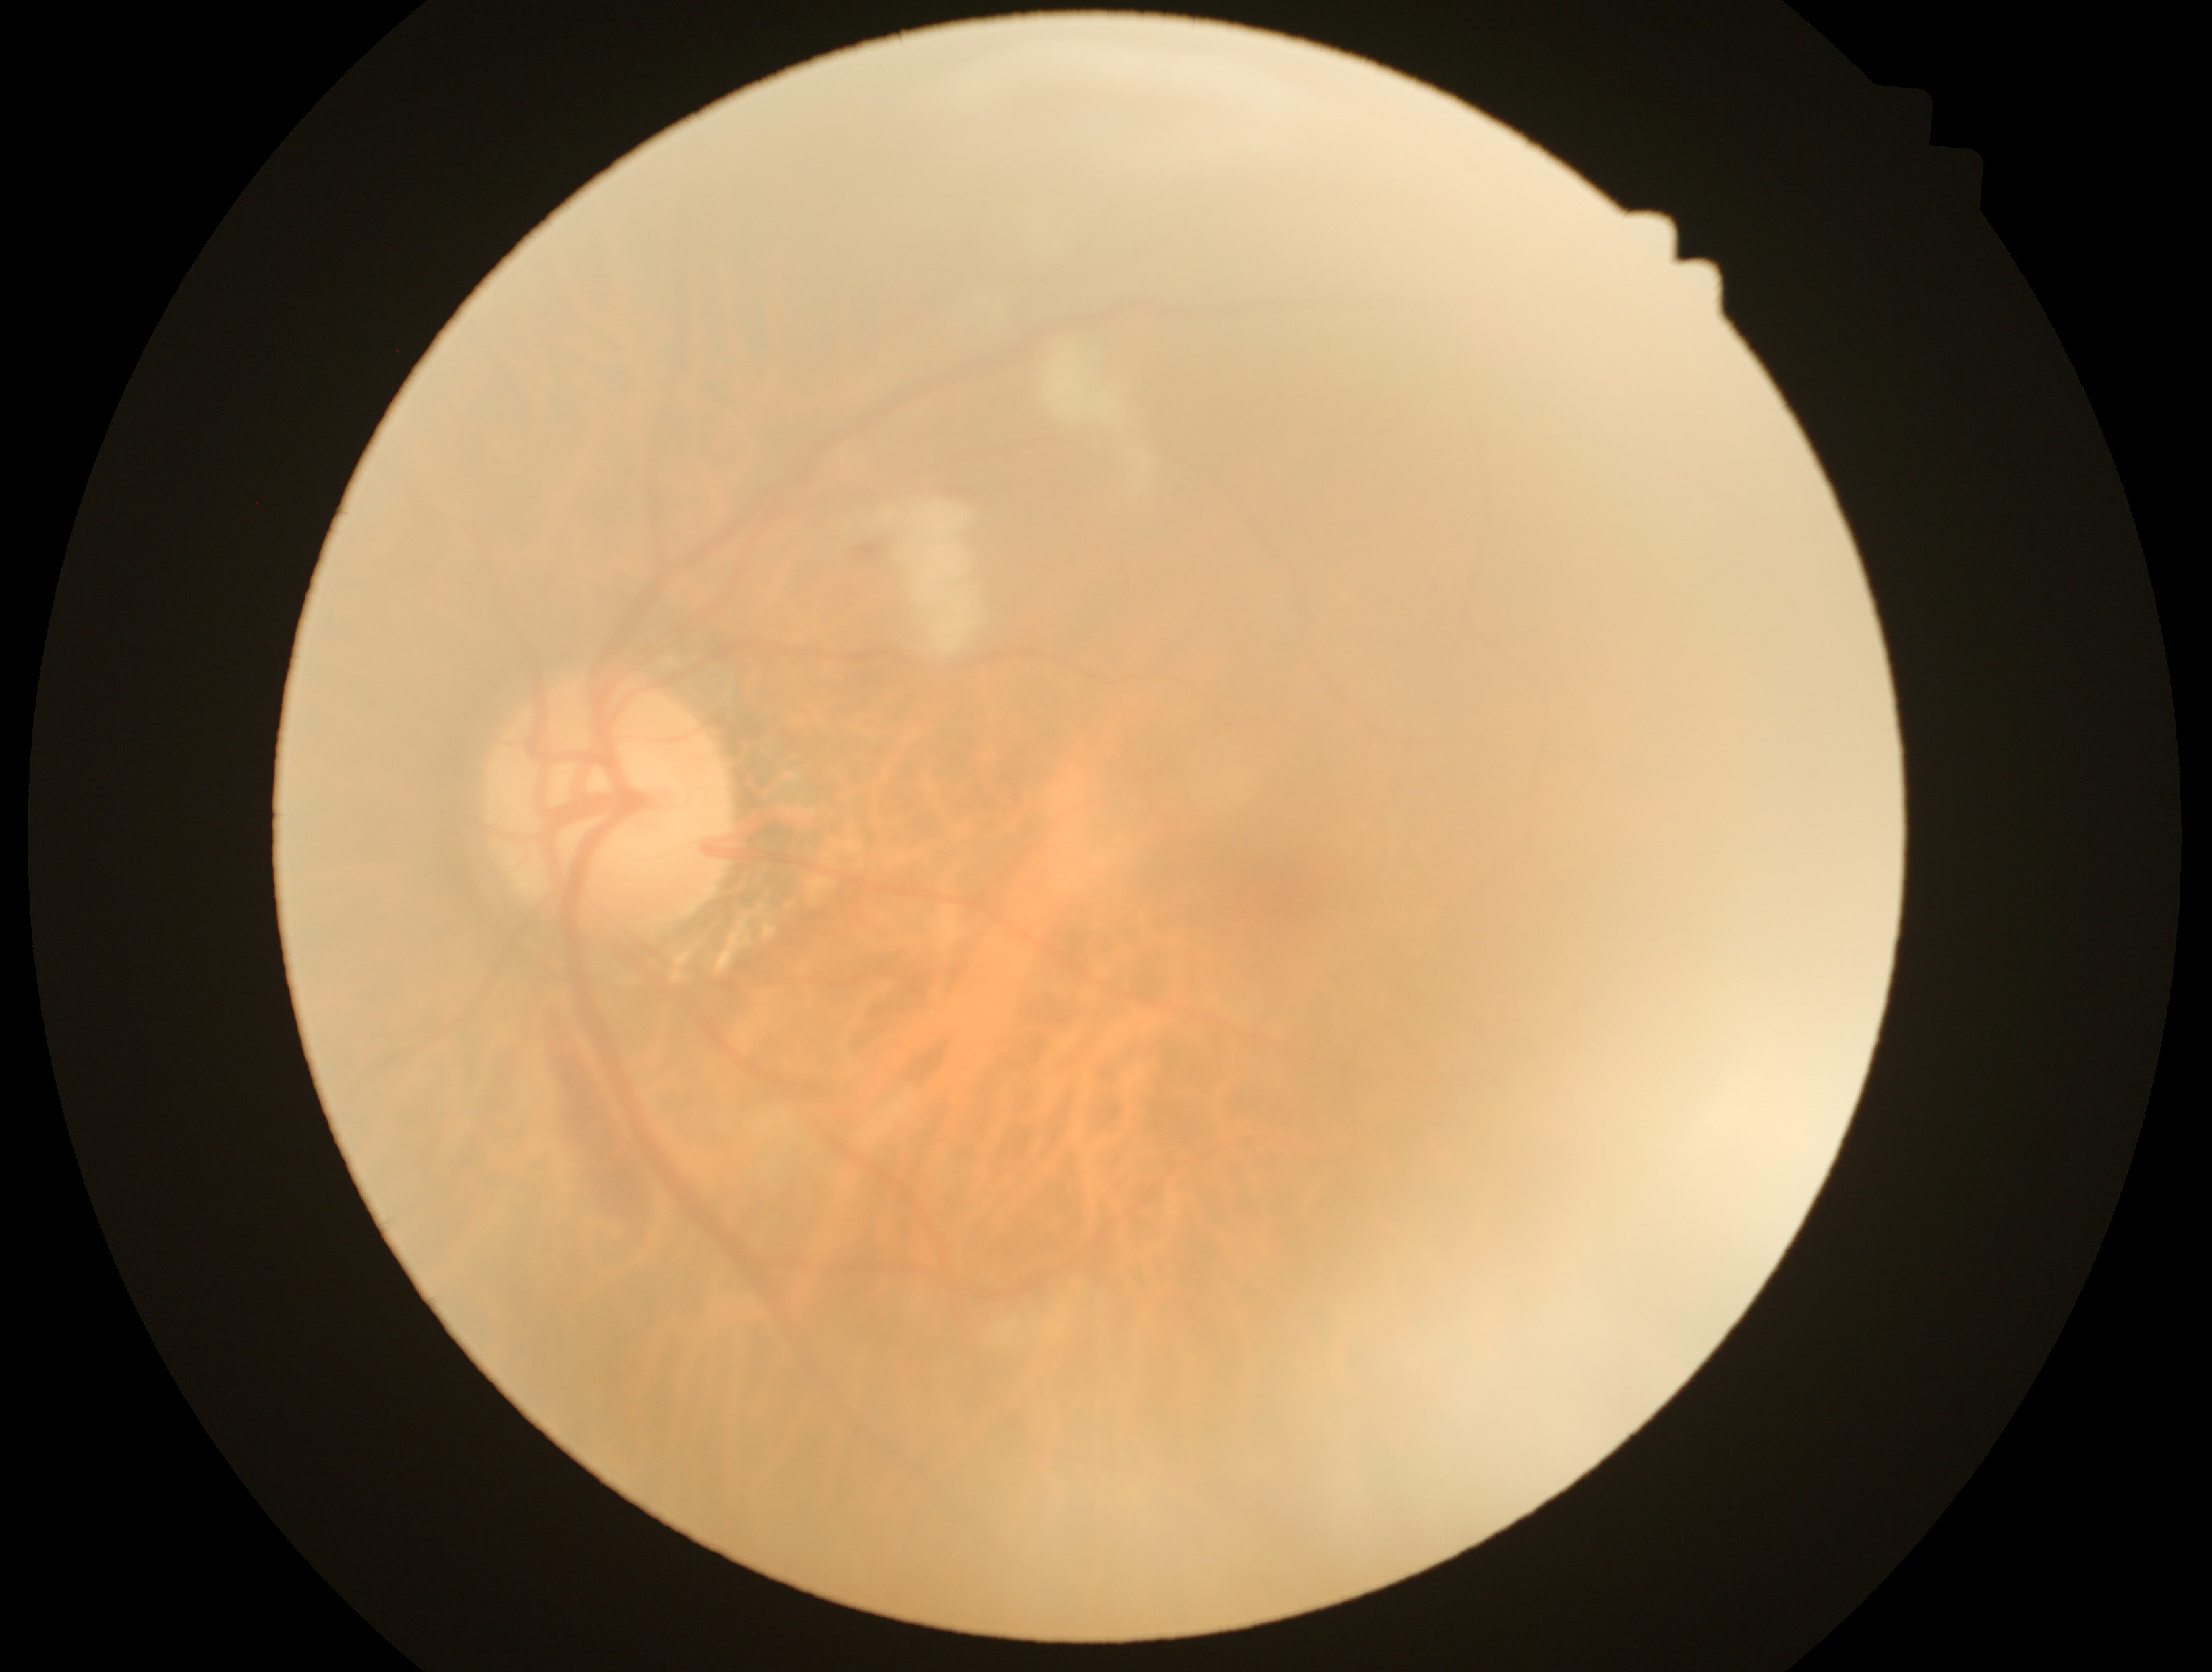 DR: moderate non-proliferative diabetic retinopathy (grade 2).
DR class: non-proliferative diabetic retinopathy.